Image size 848x848. Color fundus image. Nonmydriatic fundus photograph
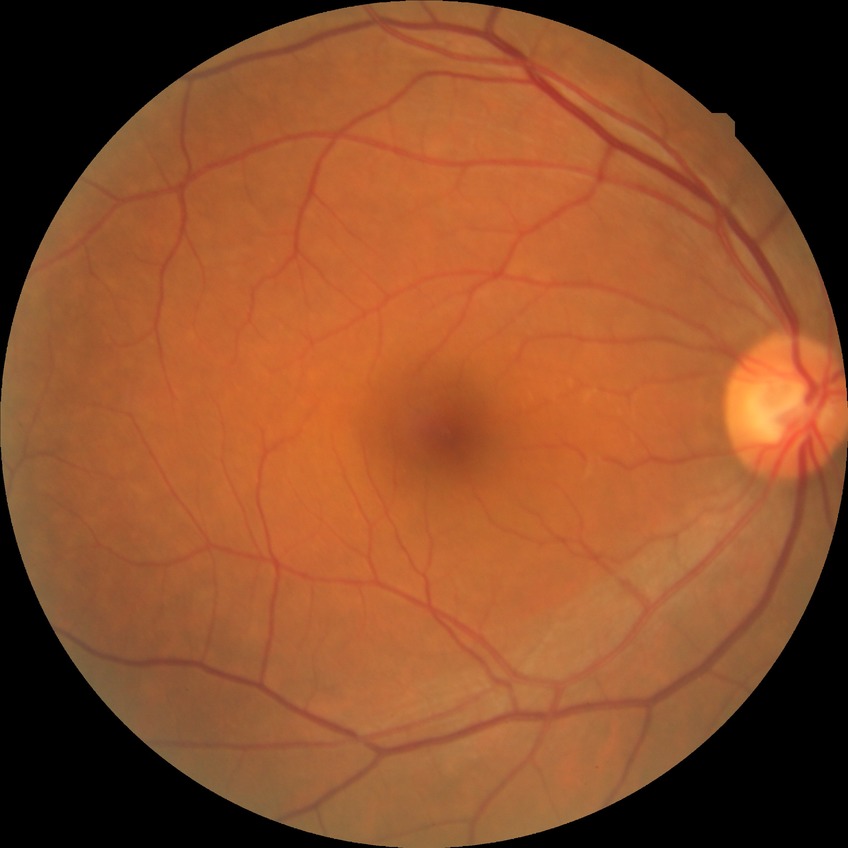
Davis grading is no diabetic retinopathy.